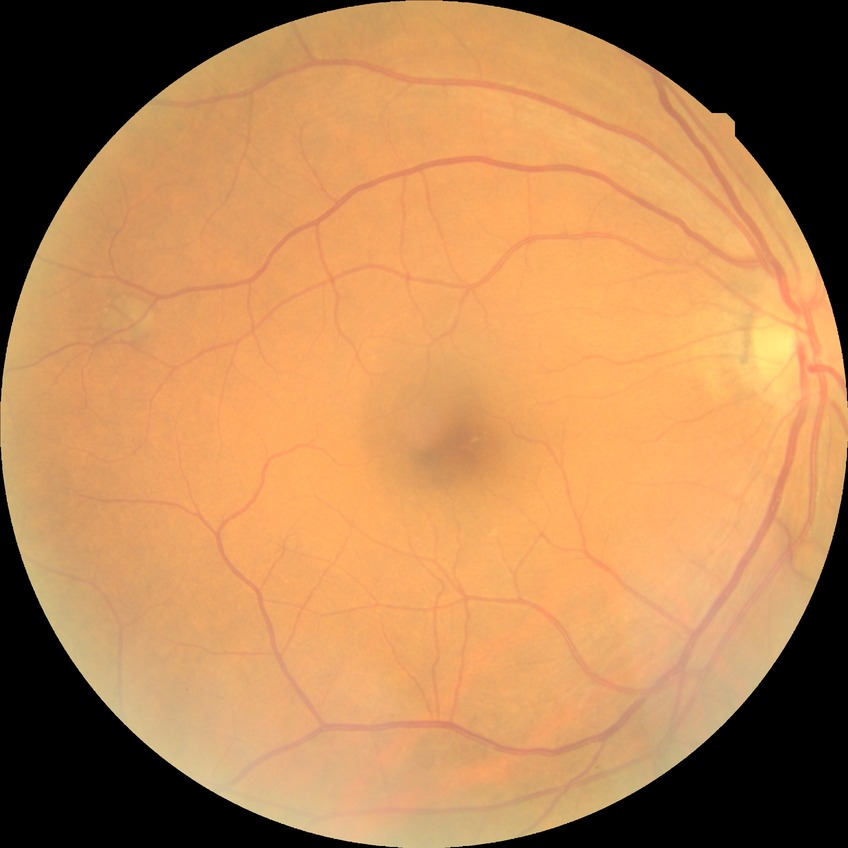 diabetic retinopathy (DR) = no diabetic retinopathy (NDR)